Posterior pole color fundus photograph; acquired with a NIDEK AFC-230; 848 x 848 pixels; 45° FOV:
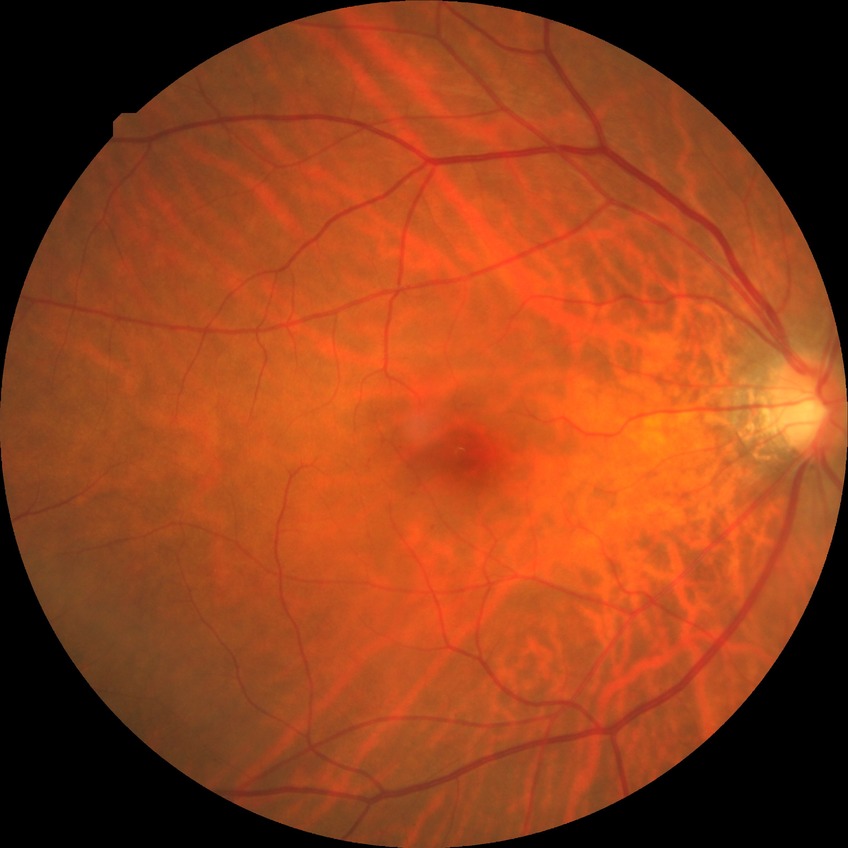
Diabetic retinopathy stage is no diabetic retinopathy.